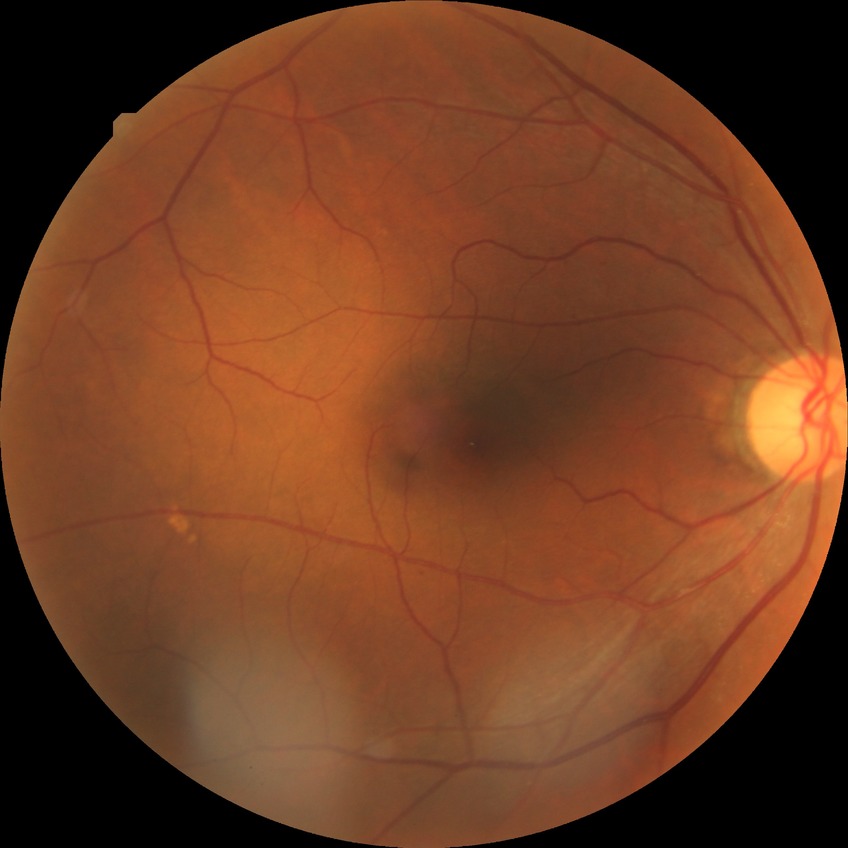 davis_grade: simple diabetic retinopathy